Modified Davis classification:
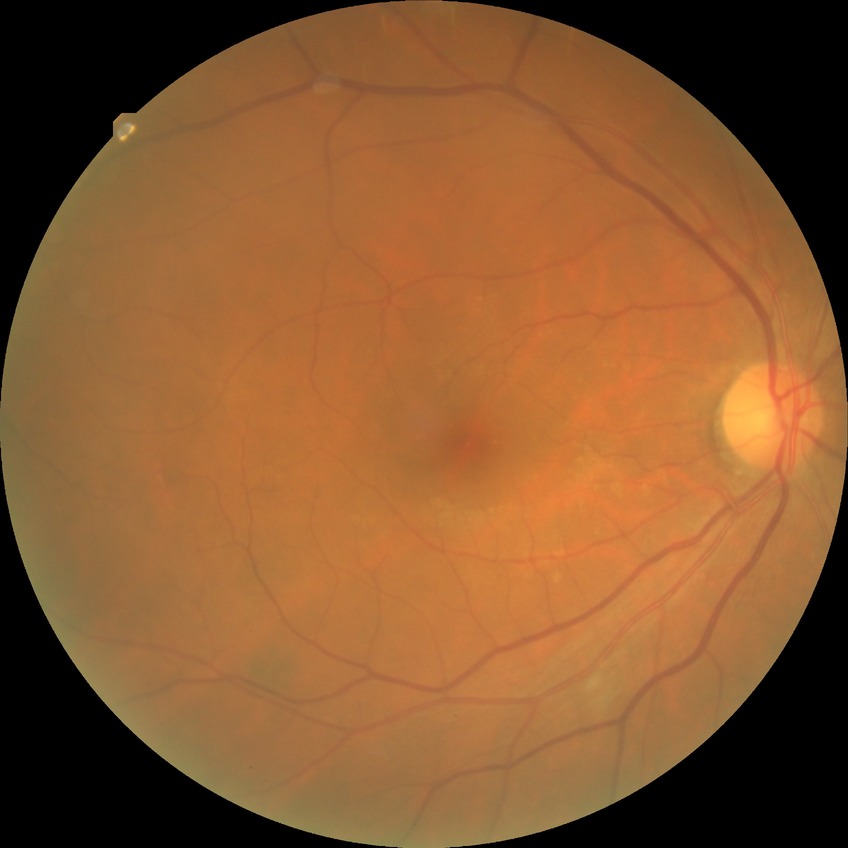

Diabetic retinopathy grade: simple diabetic retinopathy.